1659x2212px, color fundus image, Remidio Fundus on Phone:
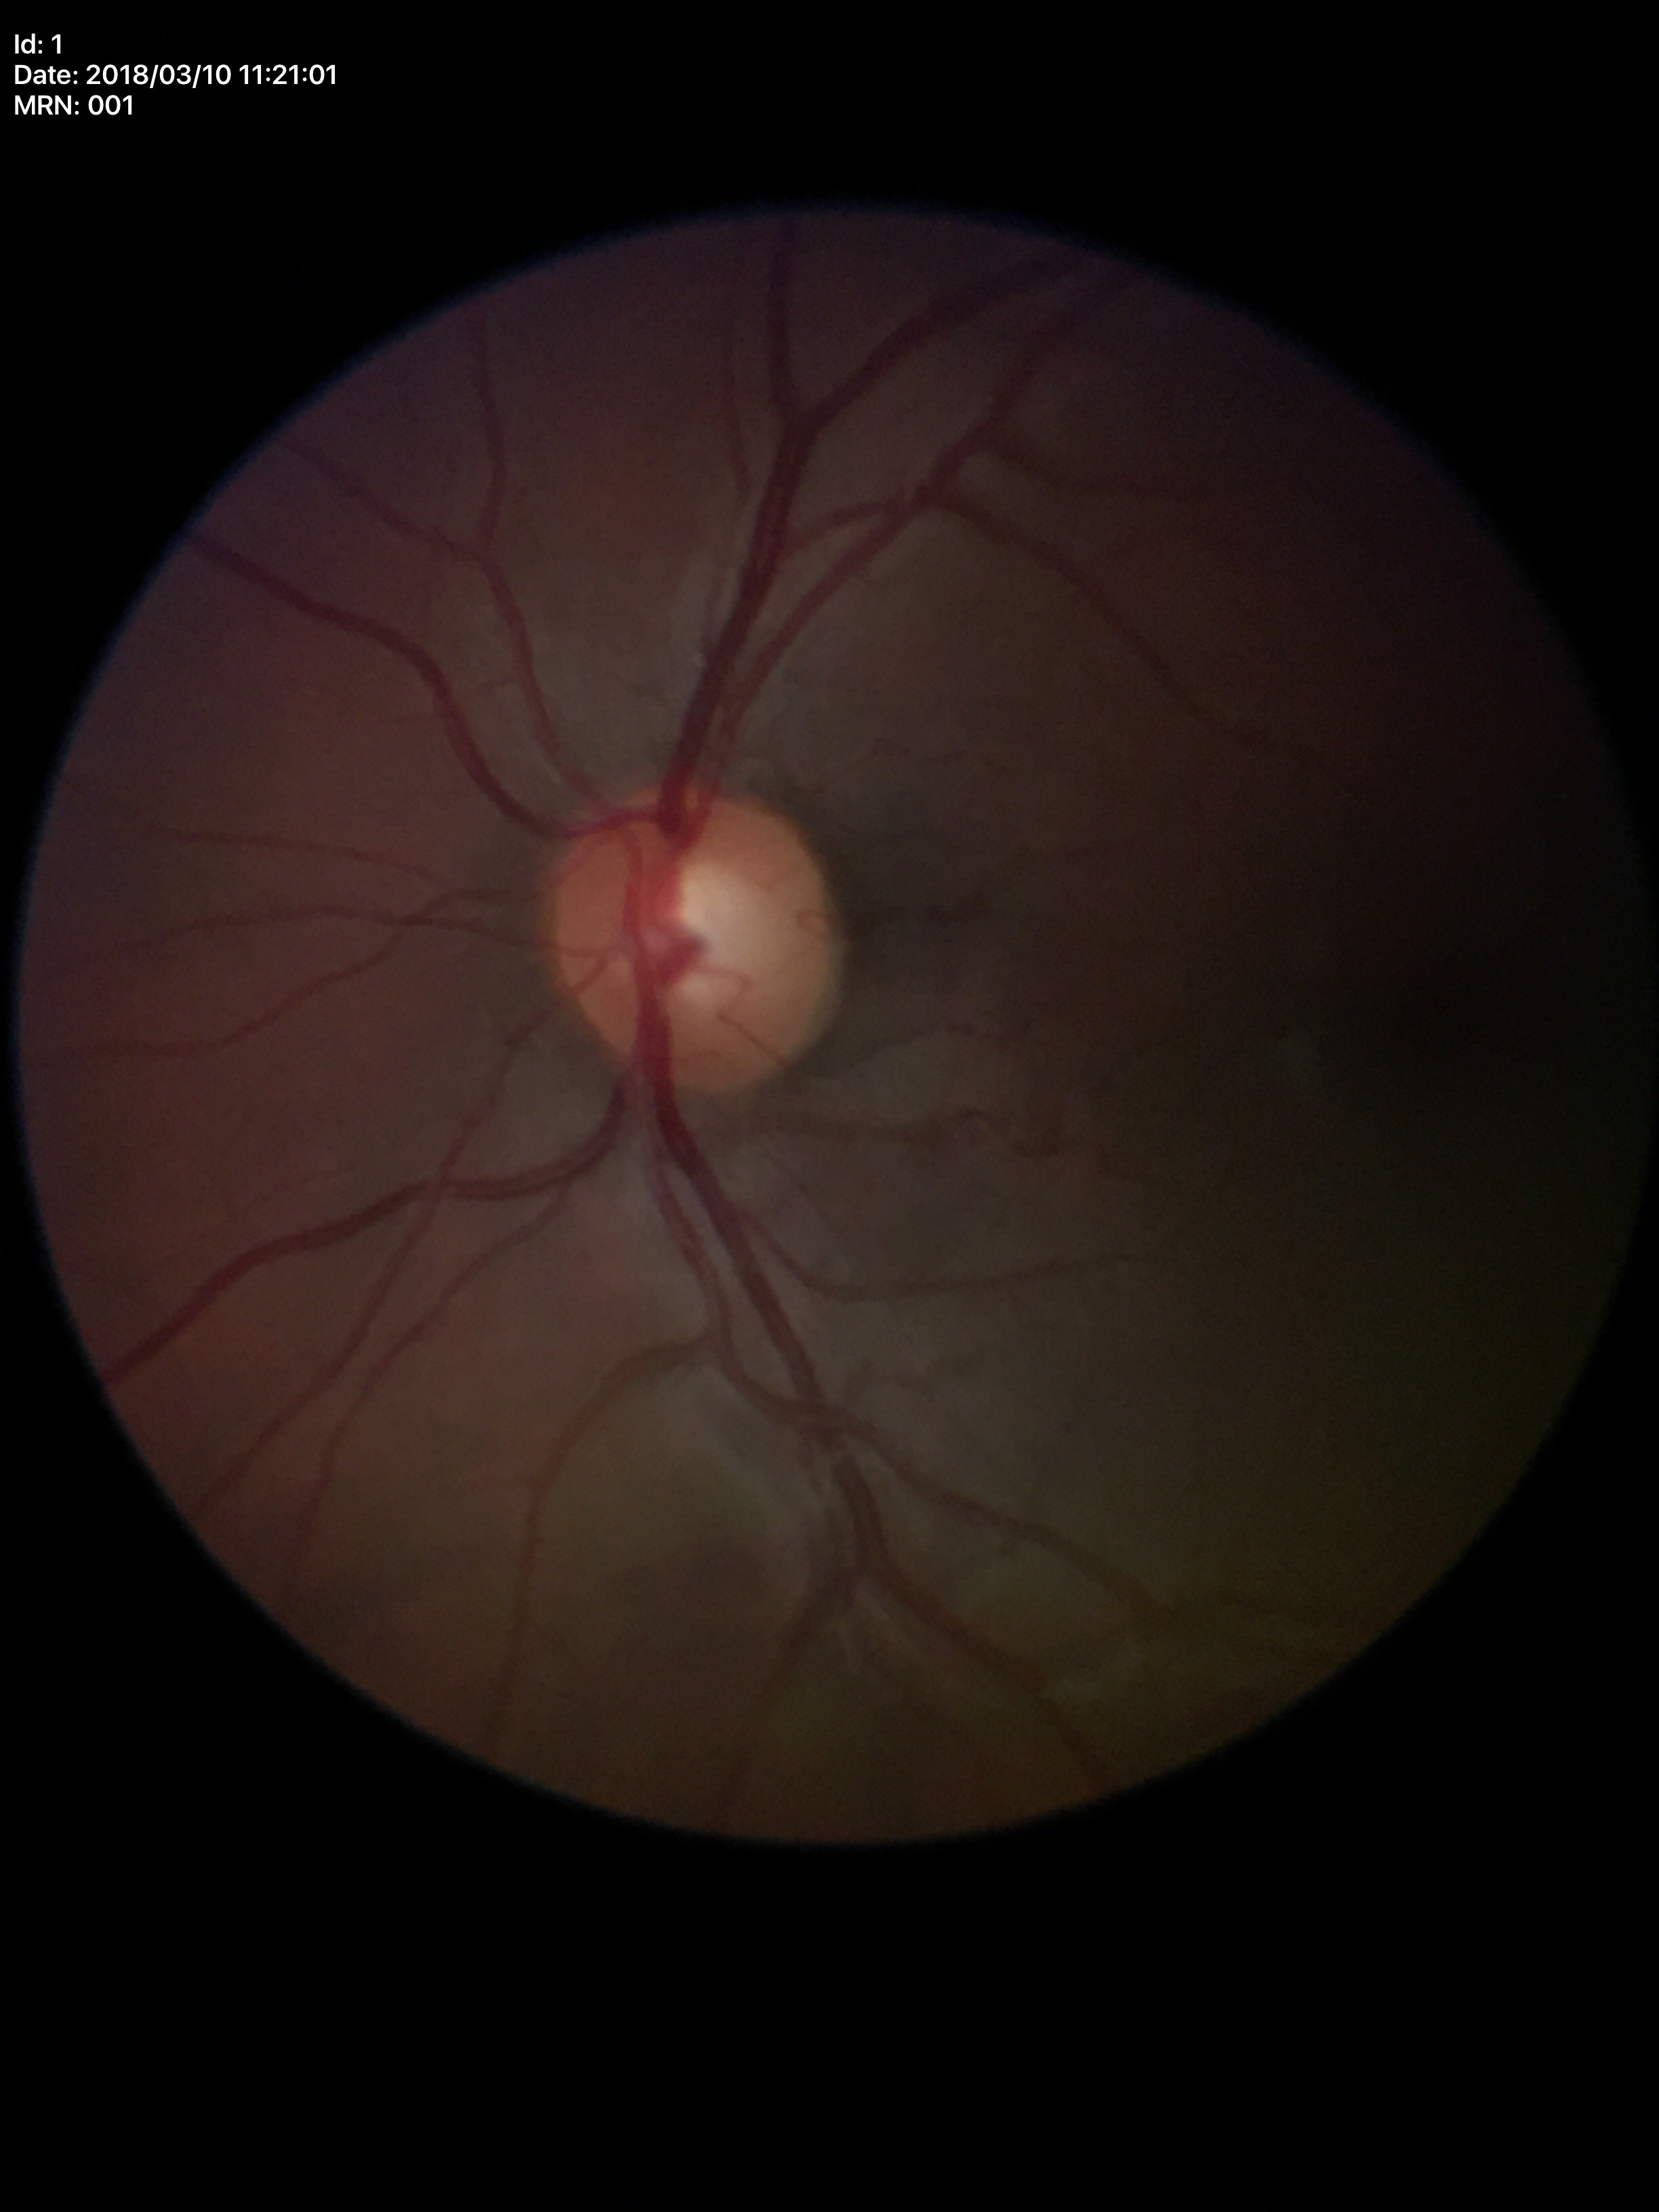 Q: Glaucoma screening result?
A: negative (1/5 graders called glaucoma suspect)
Q: What is the VCDR?
A: 0.53
Q: What is the horizontal cup-to-disc ratio?
A: 0.54